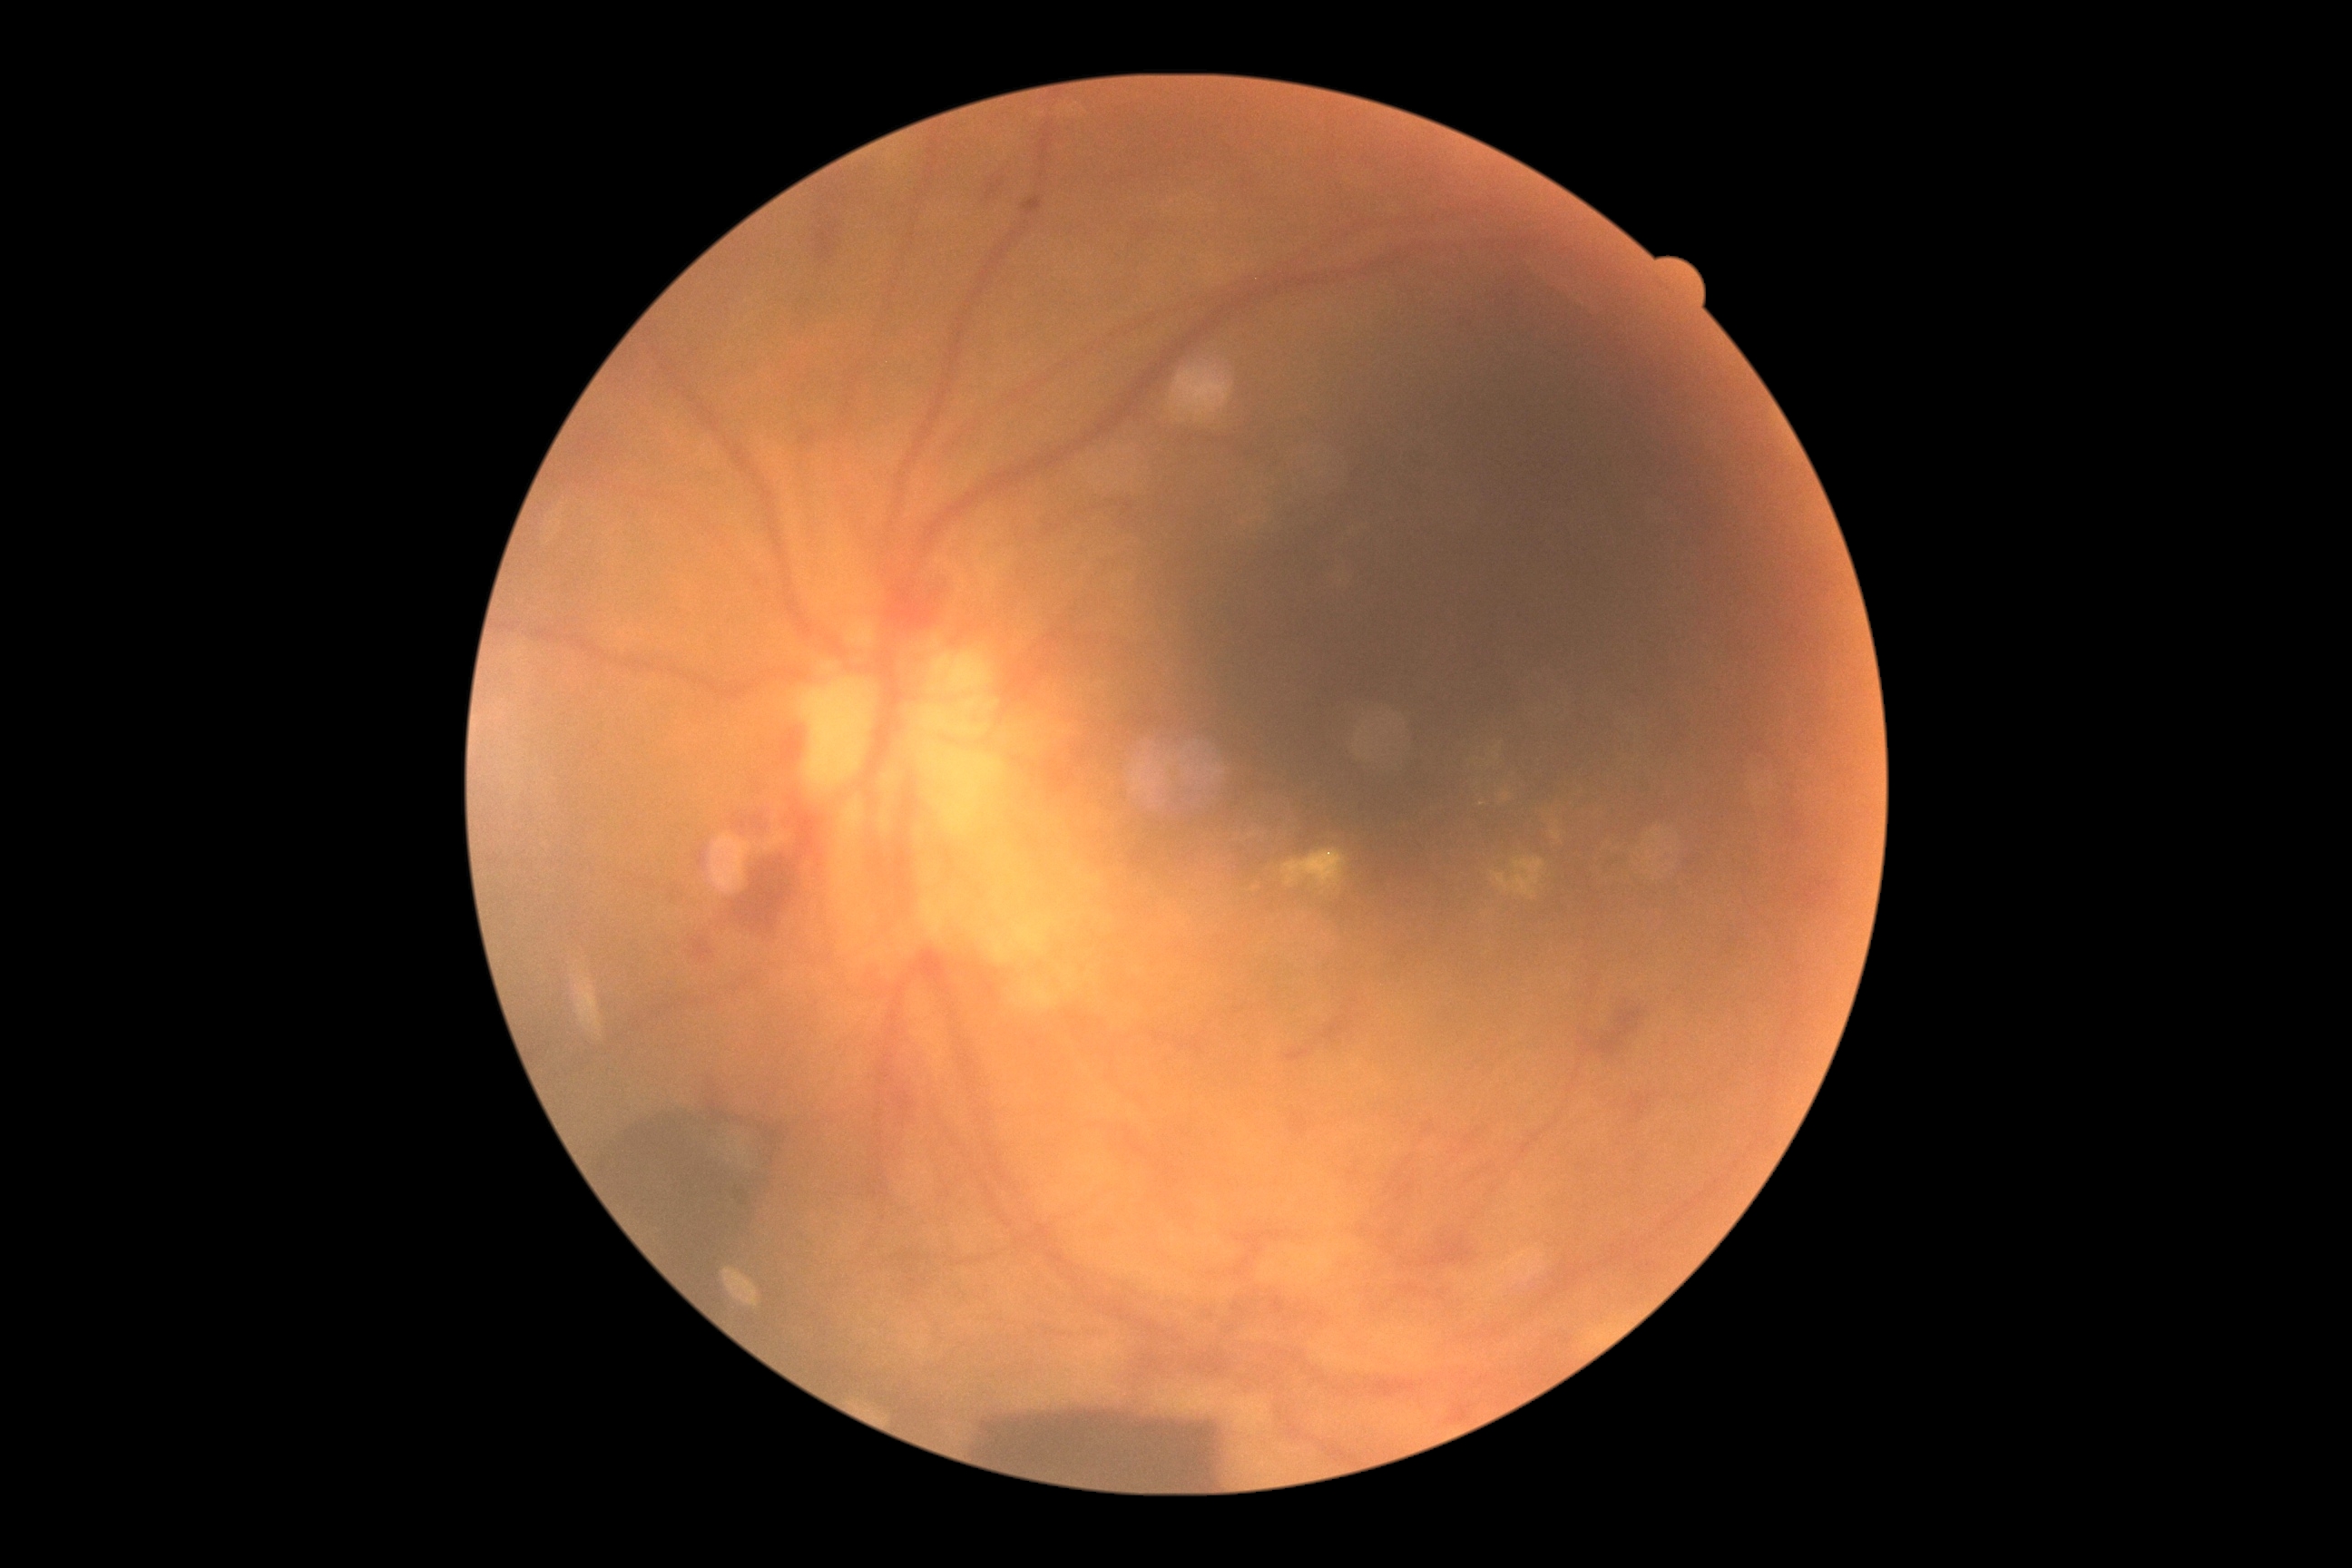
DR stage is proliferative diabetic retinopathy (grade 4).